Fundus photo — 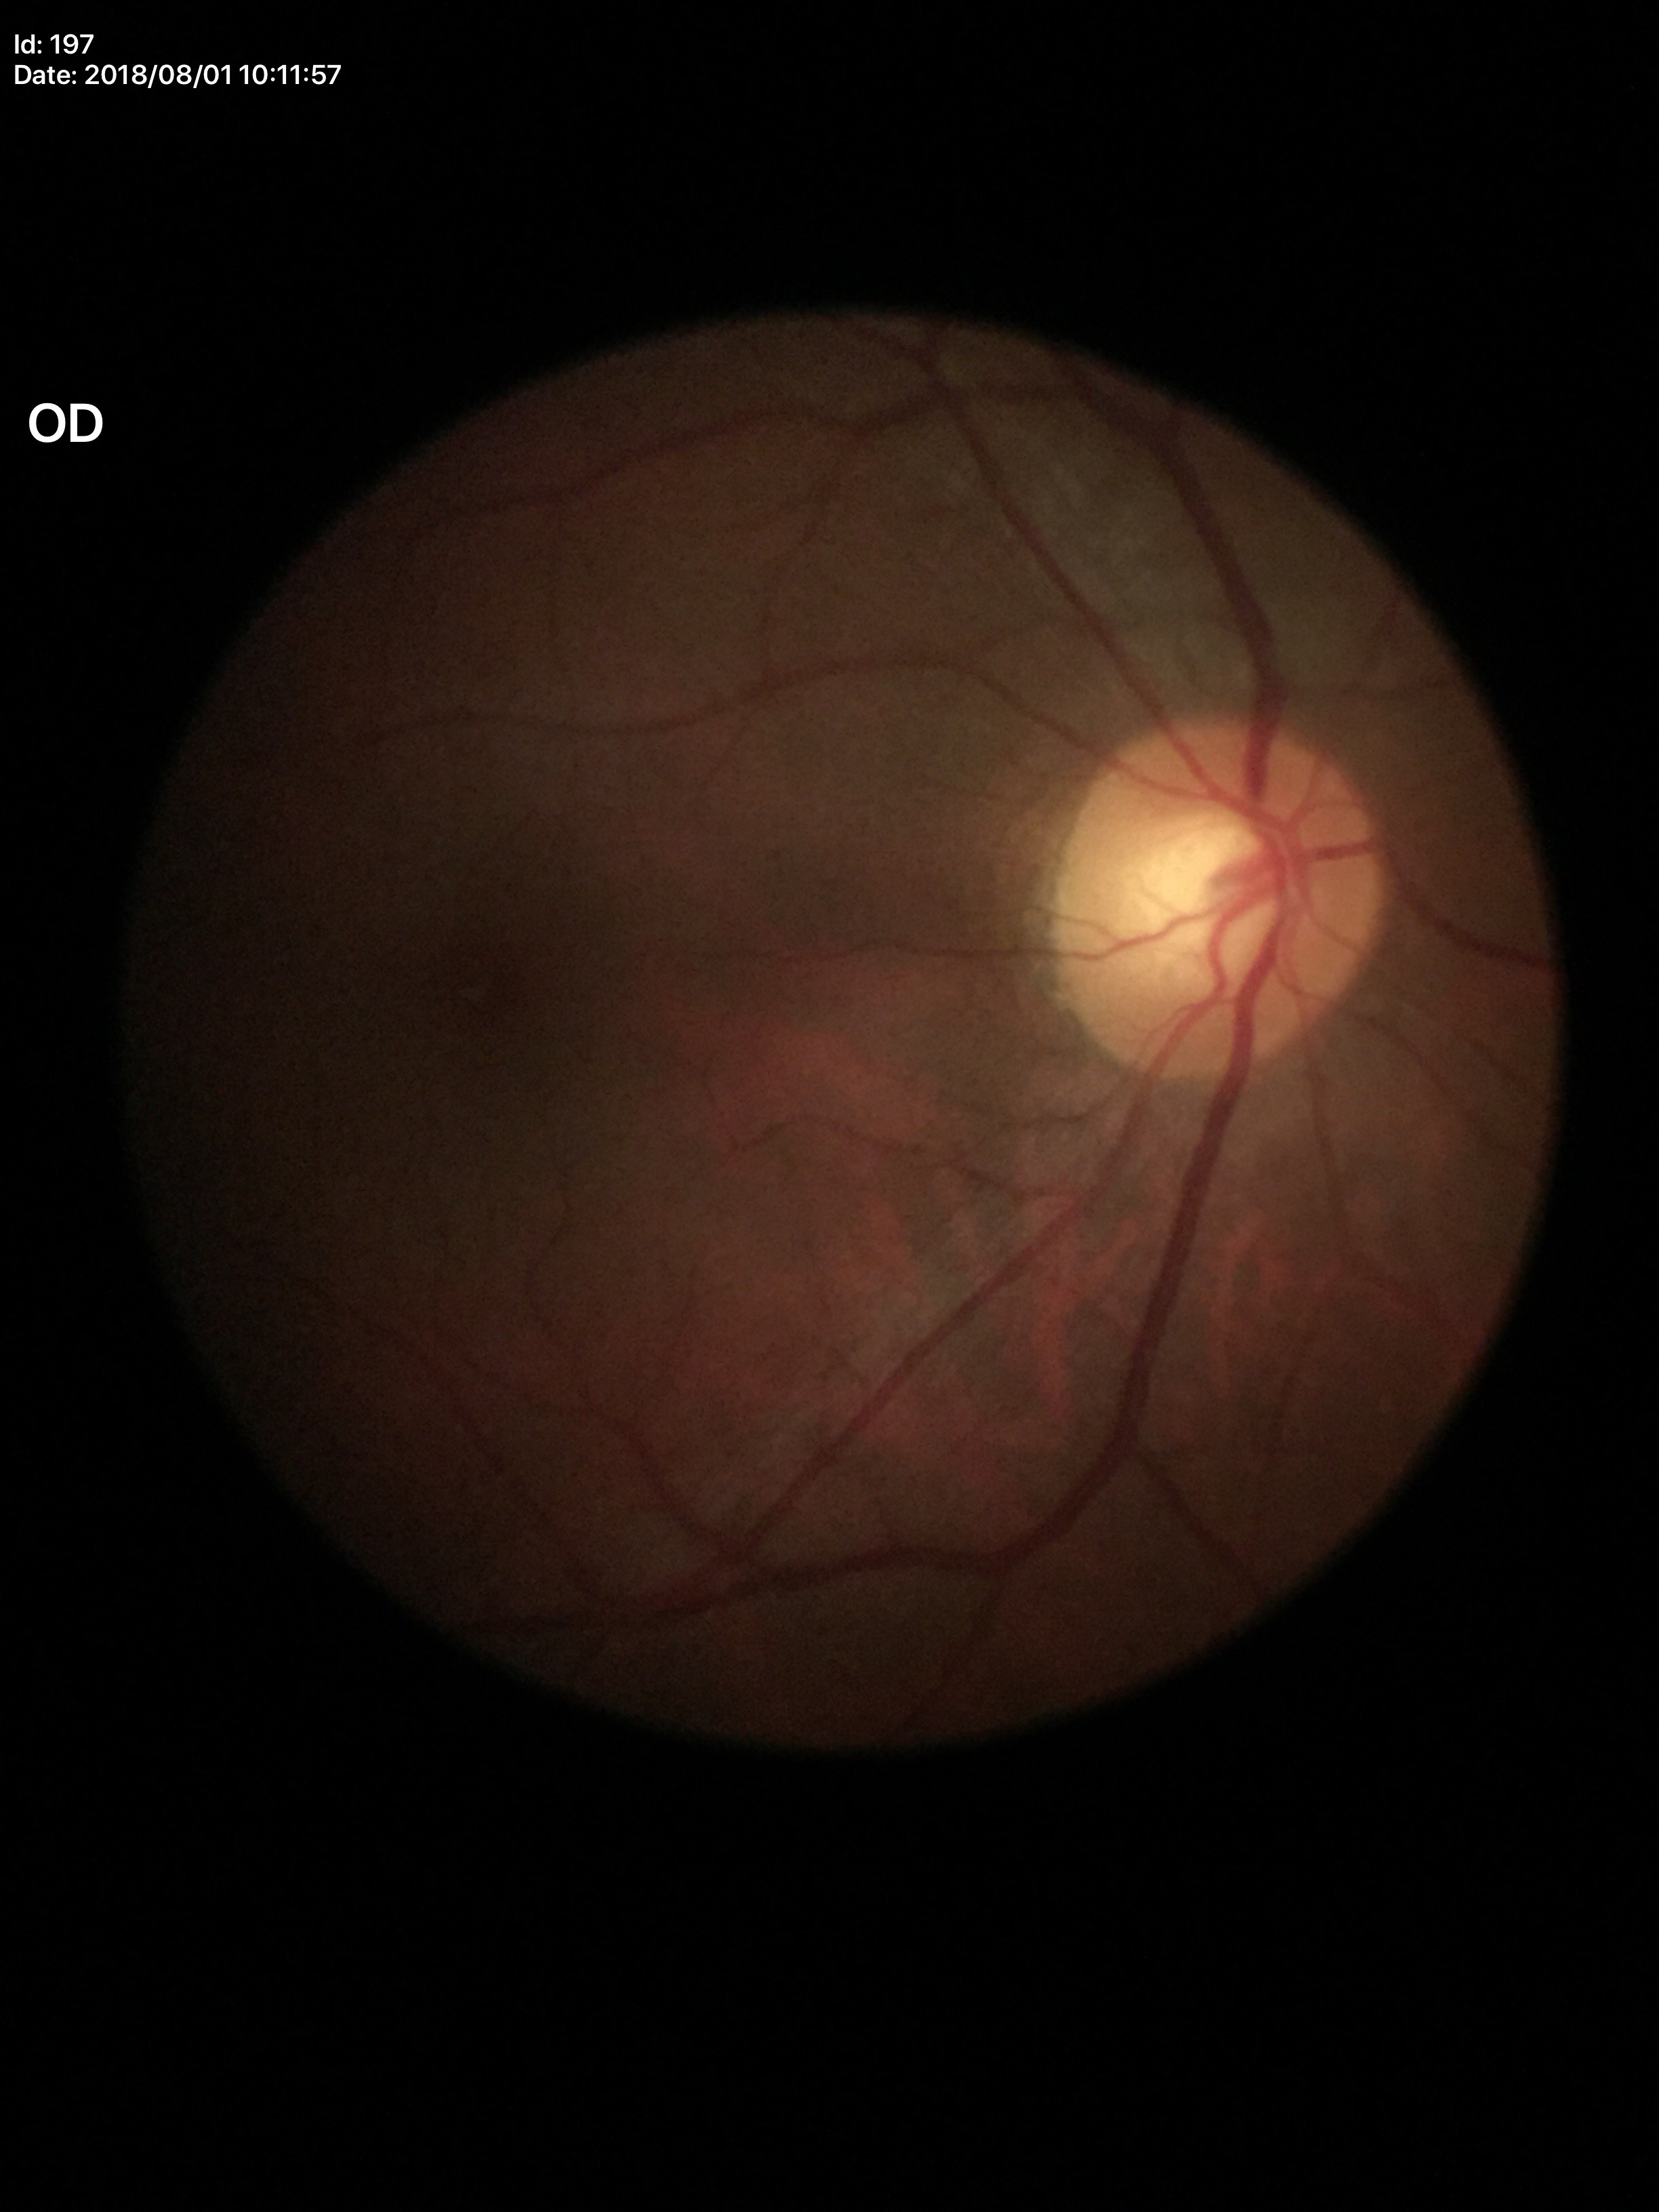

area CDR (ACDR) = 0.31; Glaucoma impression = negative; horizontal C/D ratio (HCDR) = 0.54; vertical C/D ratio (VCDR) = 0.56.